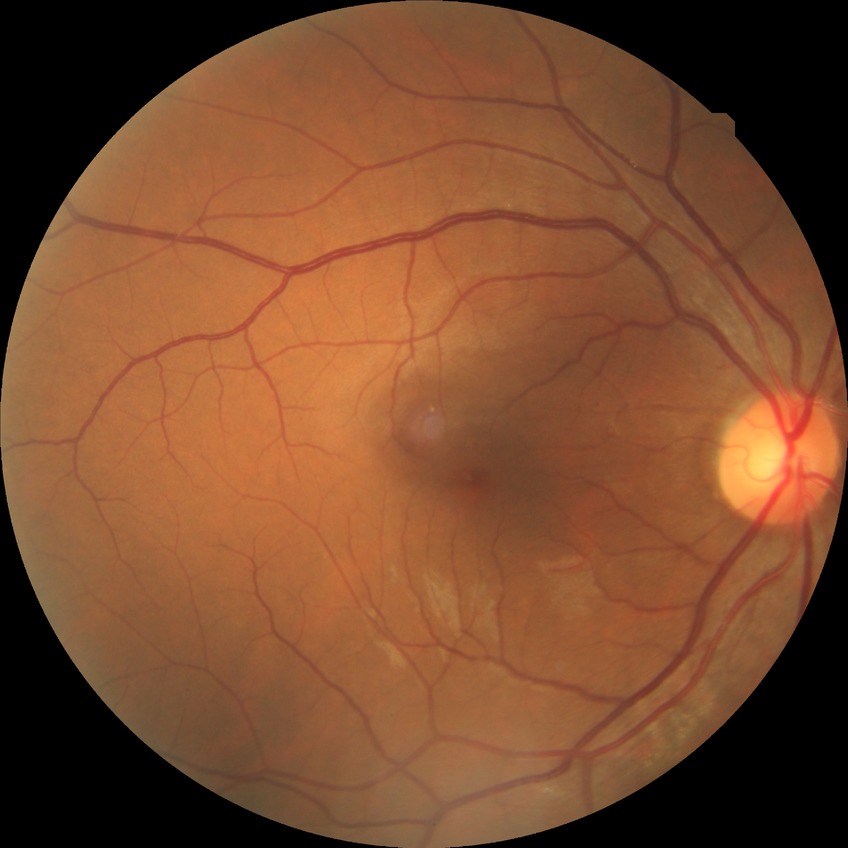   davis_grade: no diabetic retinopathy